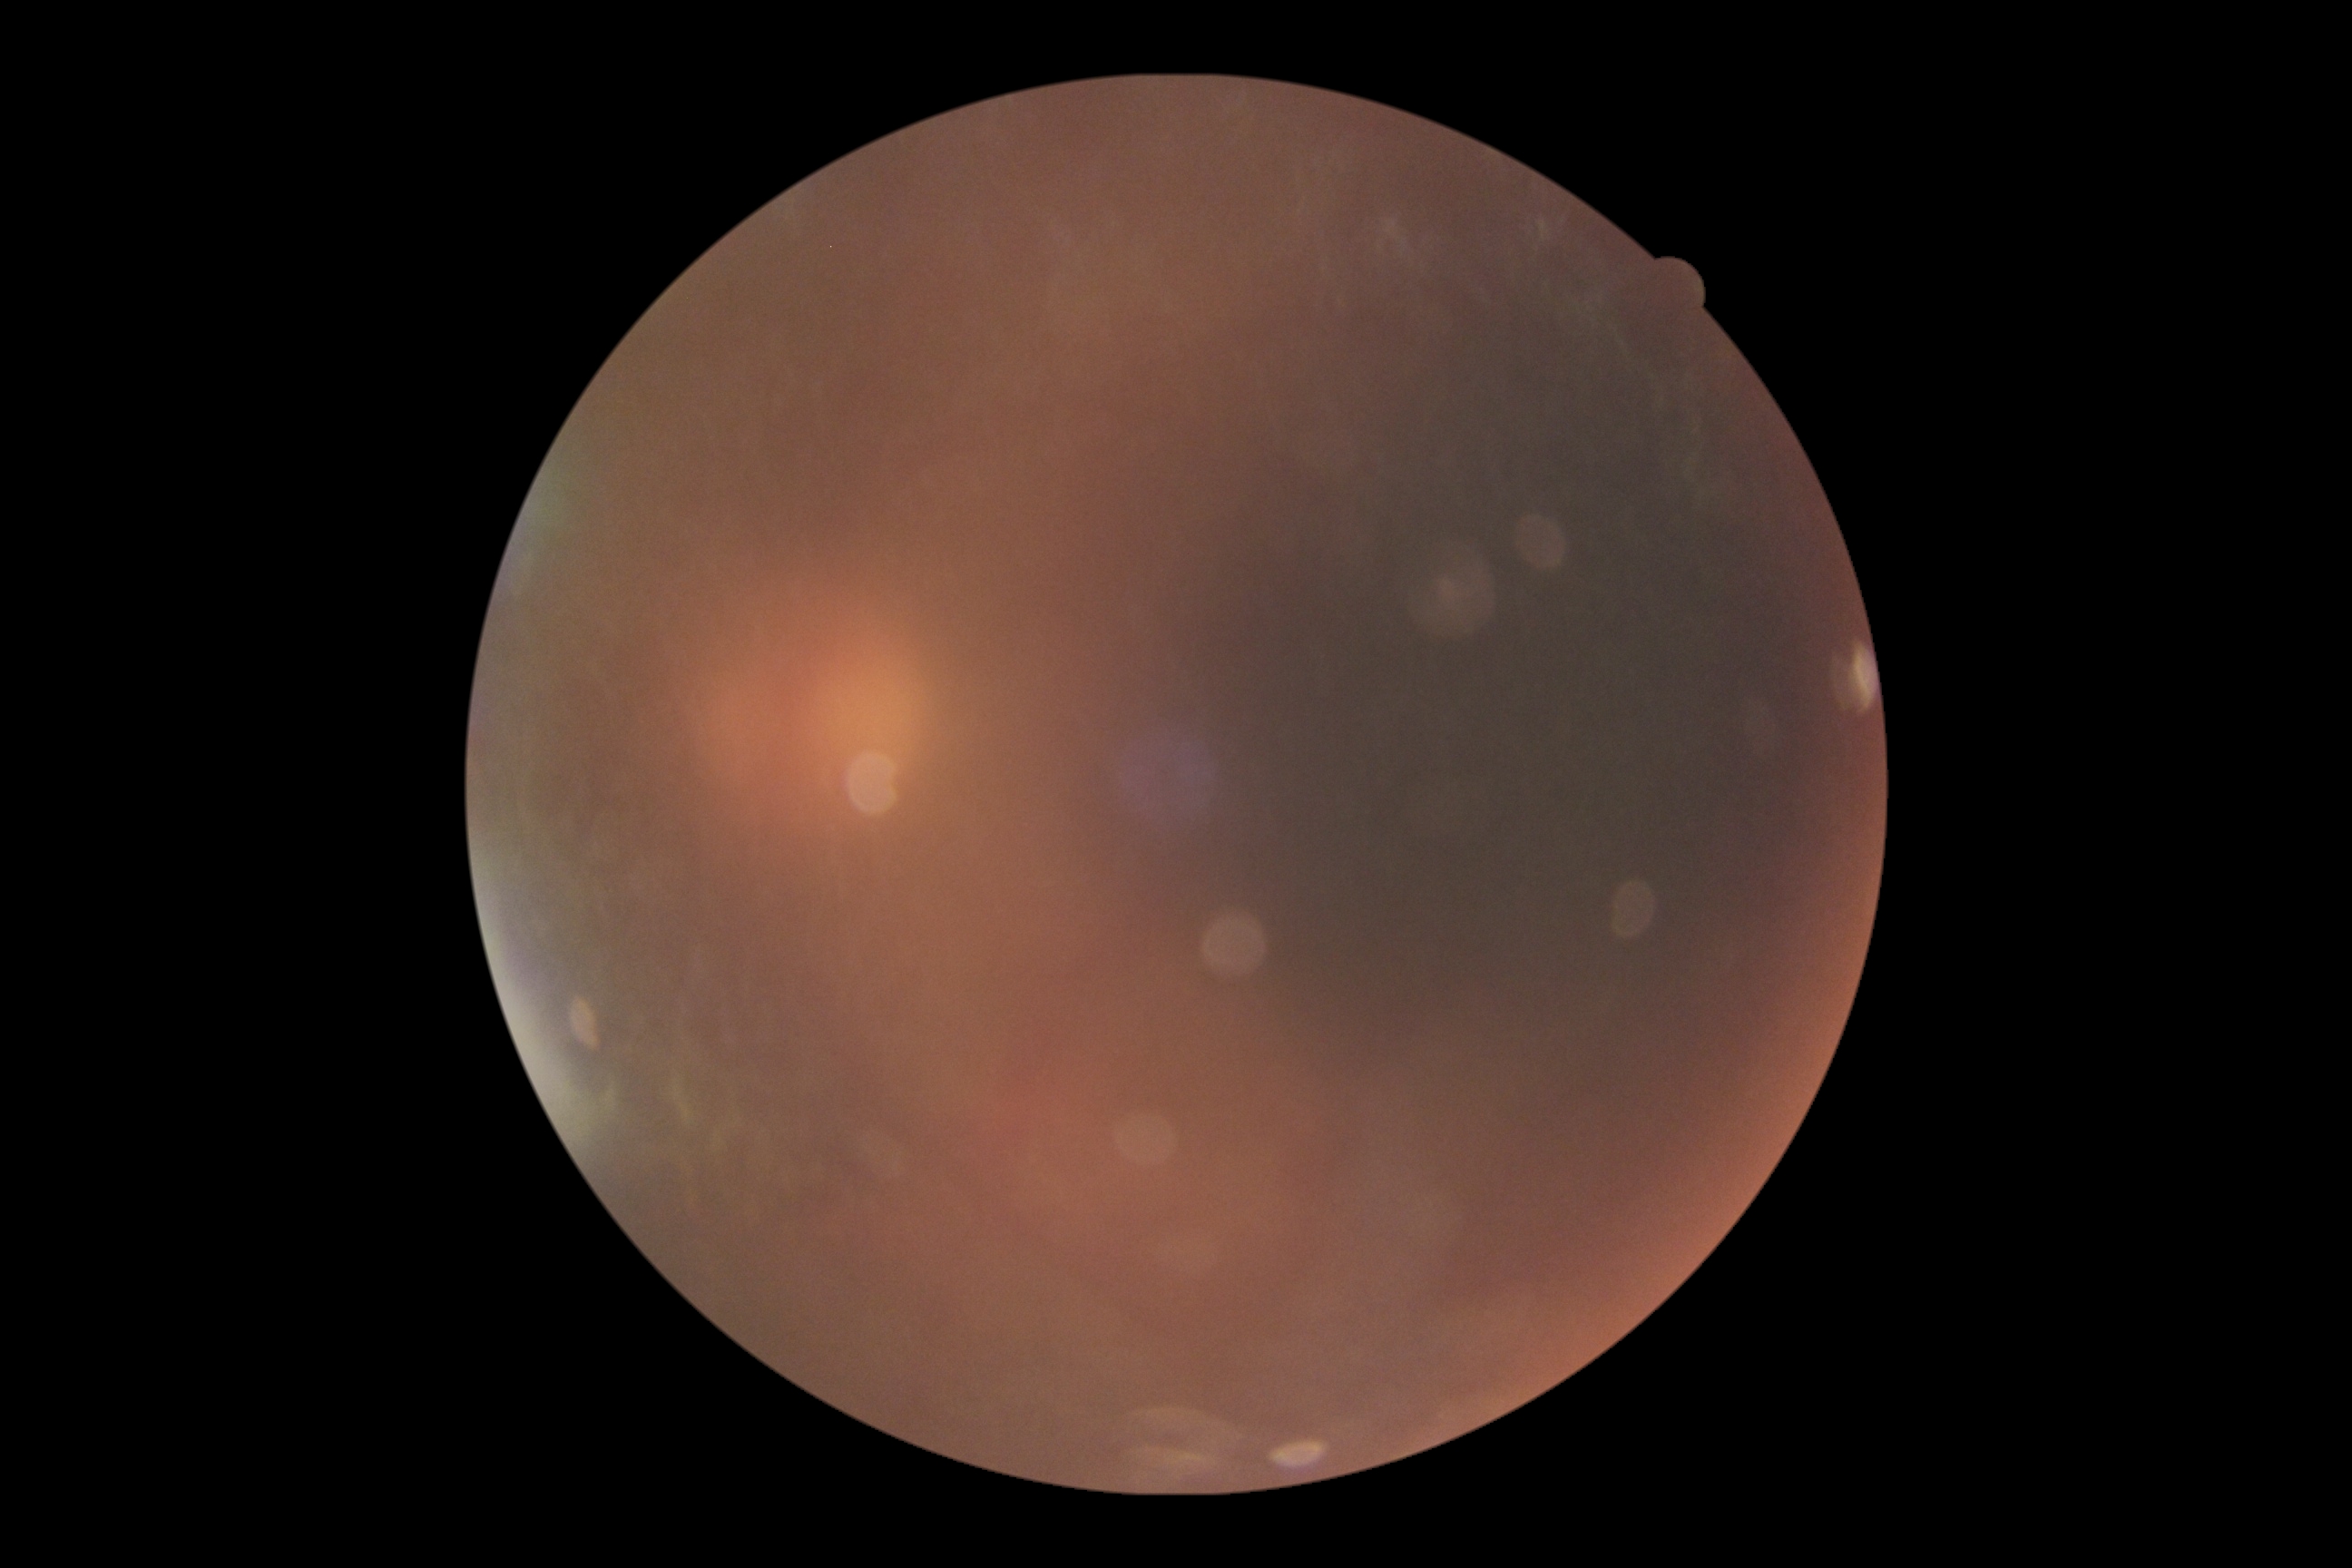

Image quality is insufficient for diabetic retinopathy assessment. Retinopathy grade is ungradable due to poor image quality.